Wide-field fundus image from infant ROP screening. Camera: Clarity RetCam 3 (130° FOV) — 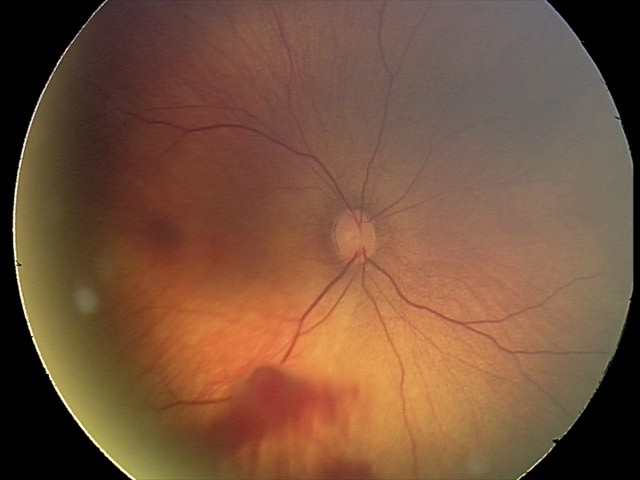
From an examination with diagnosis of retinal hemorrhages.